Infant wide-field fundus photograph
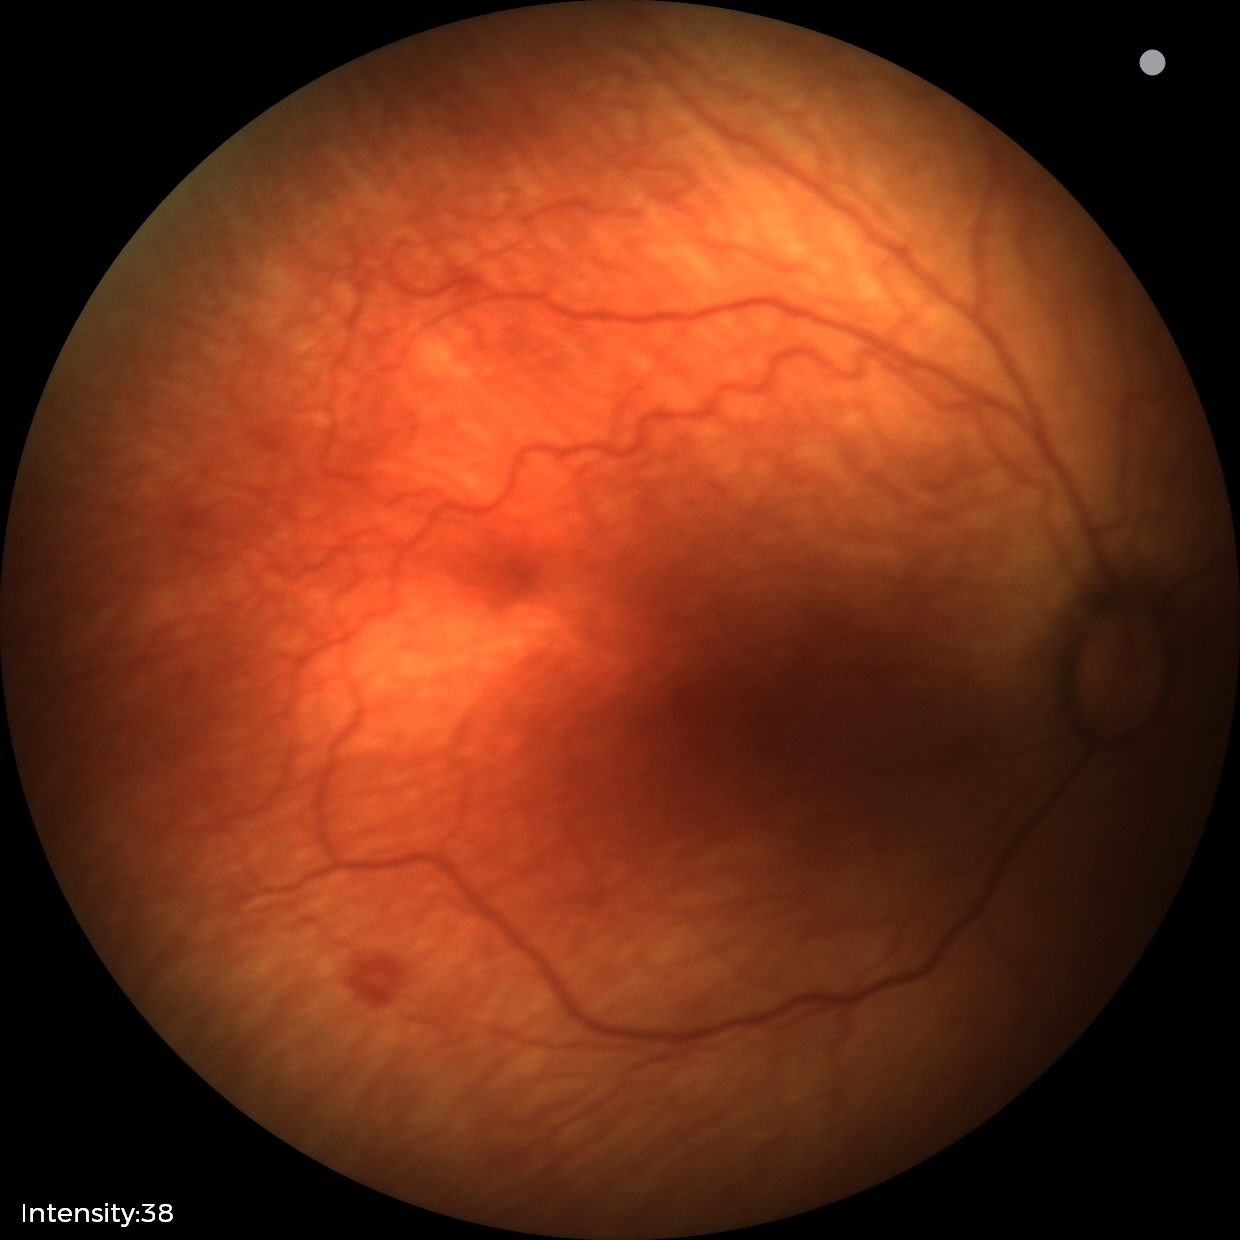
Screening diagnosis: no plus disease; retinopathy of prematurity stage 1.